Image size 1924x1556 · ultra-widefield fundus photograph · 200° FOV — 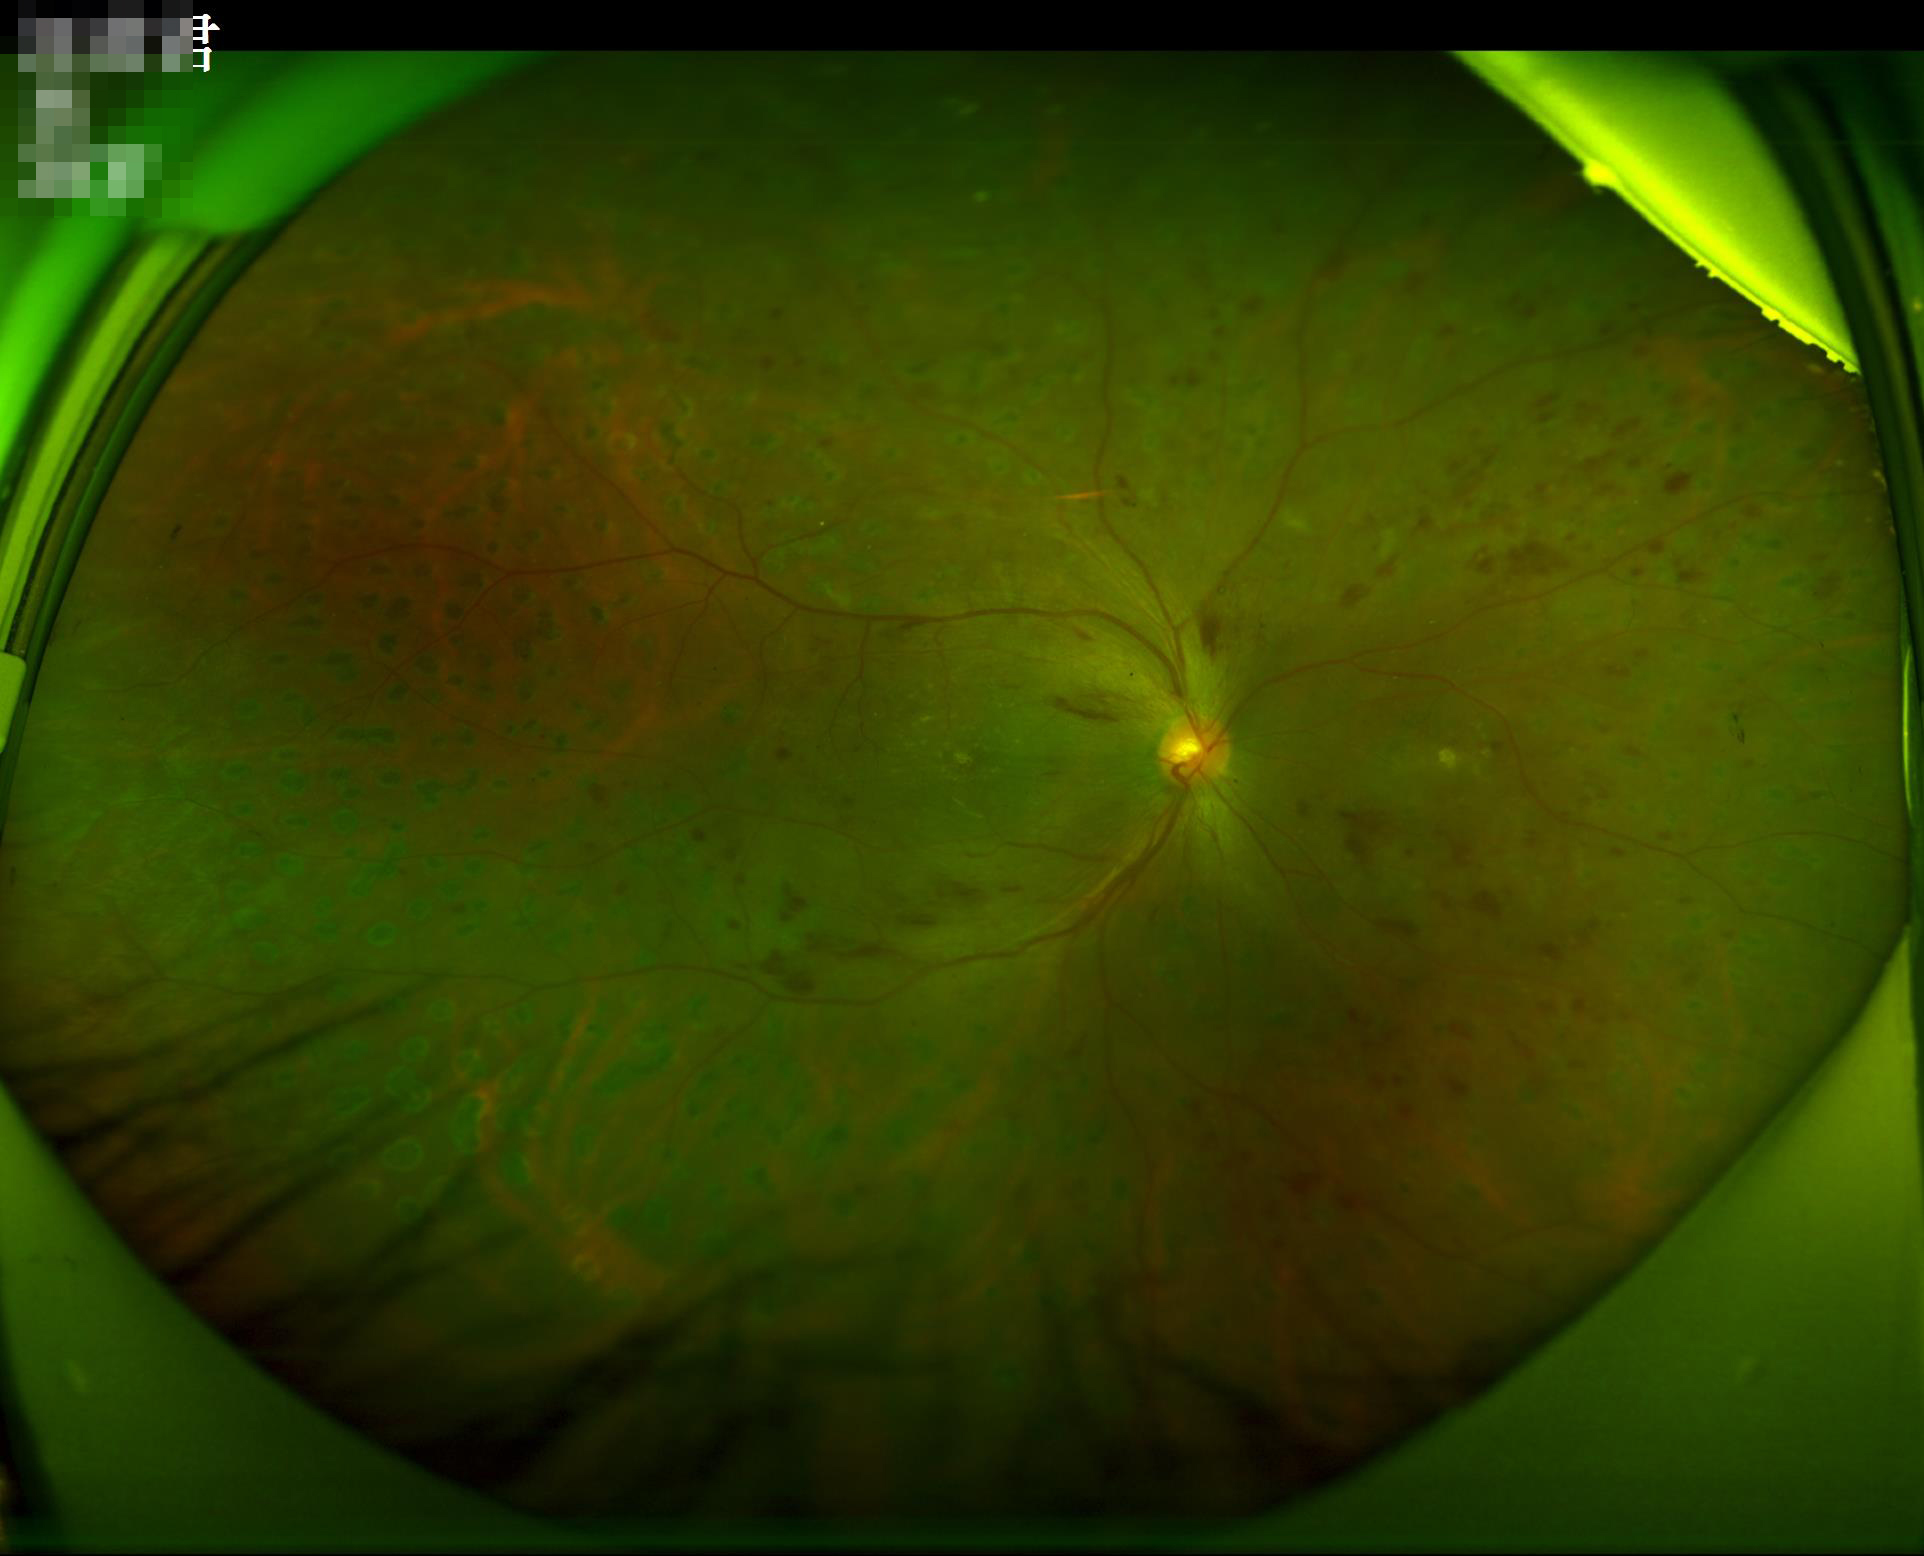 Quality grading: sharpness: good; illumination/color: satisfactory; overall: acceptable.